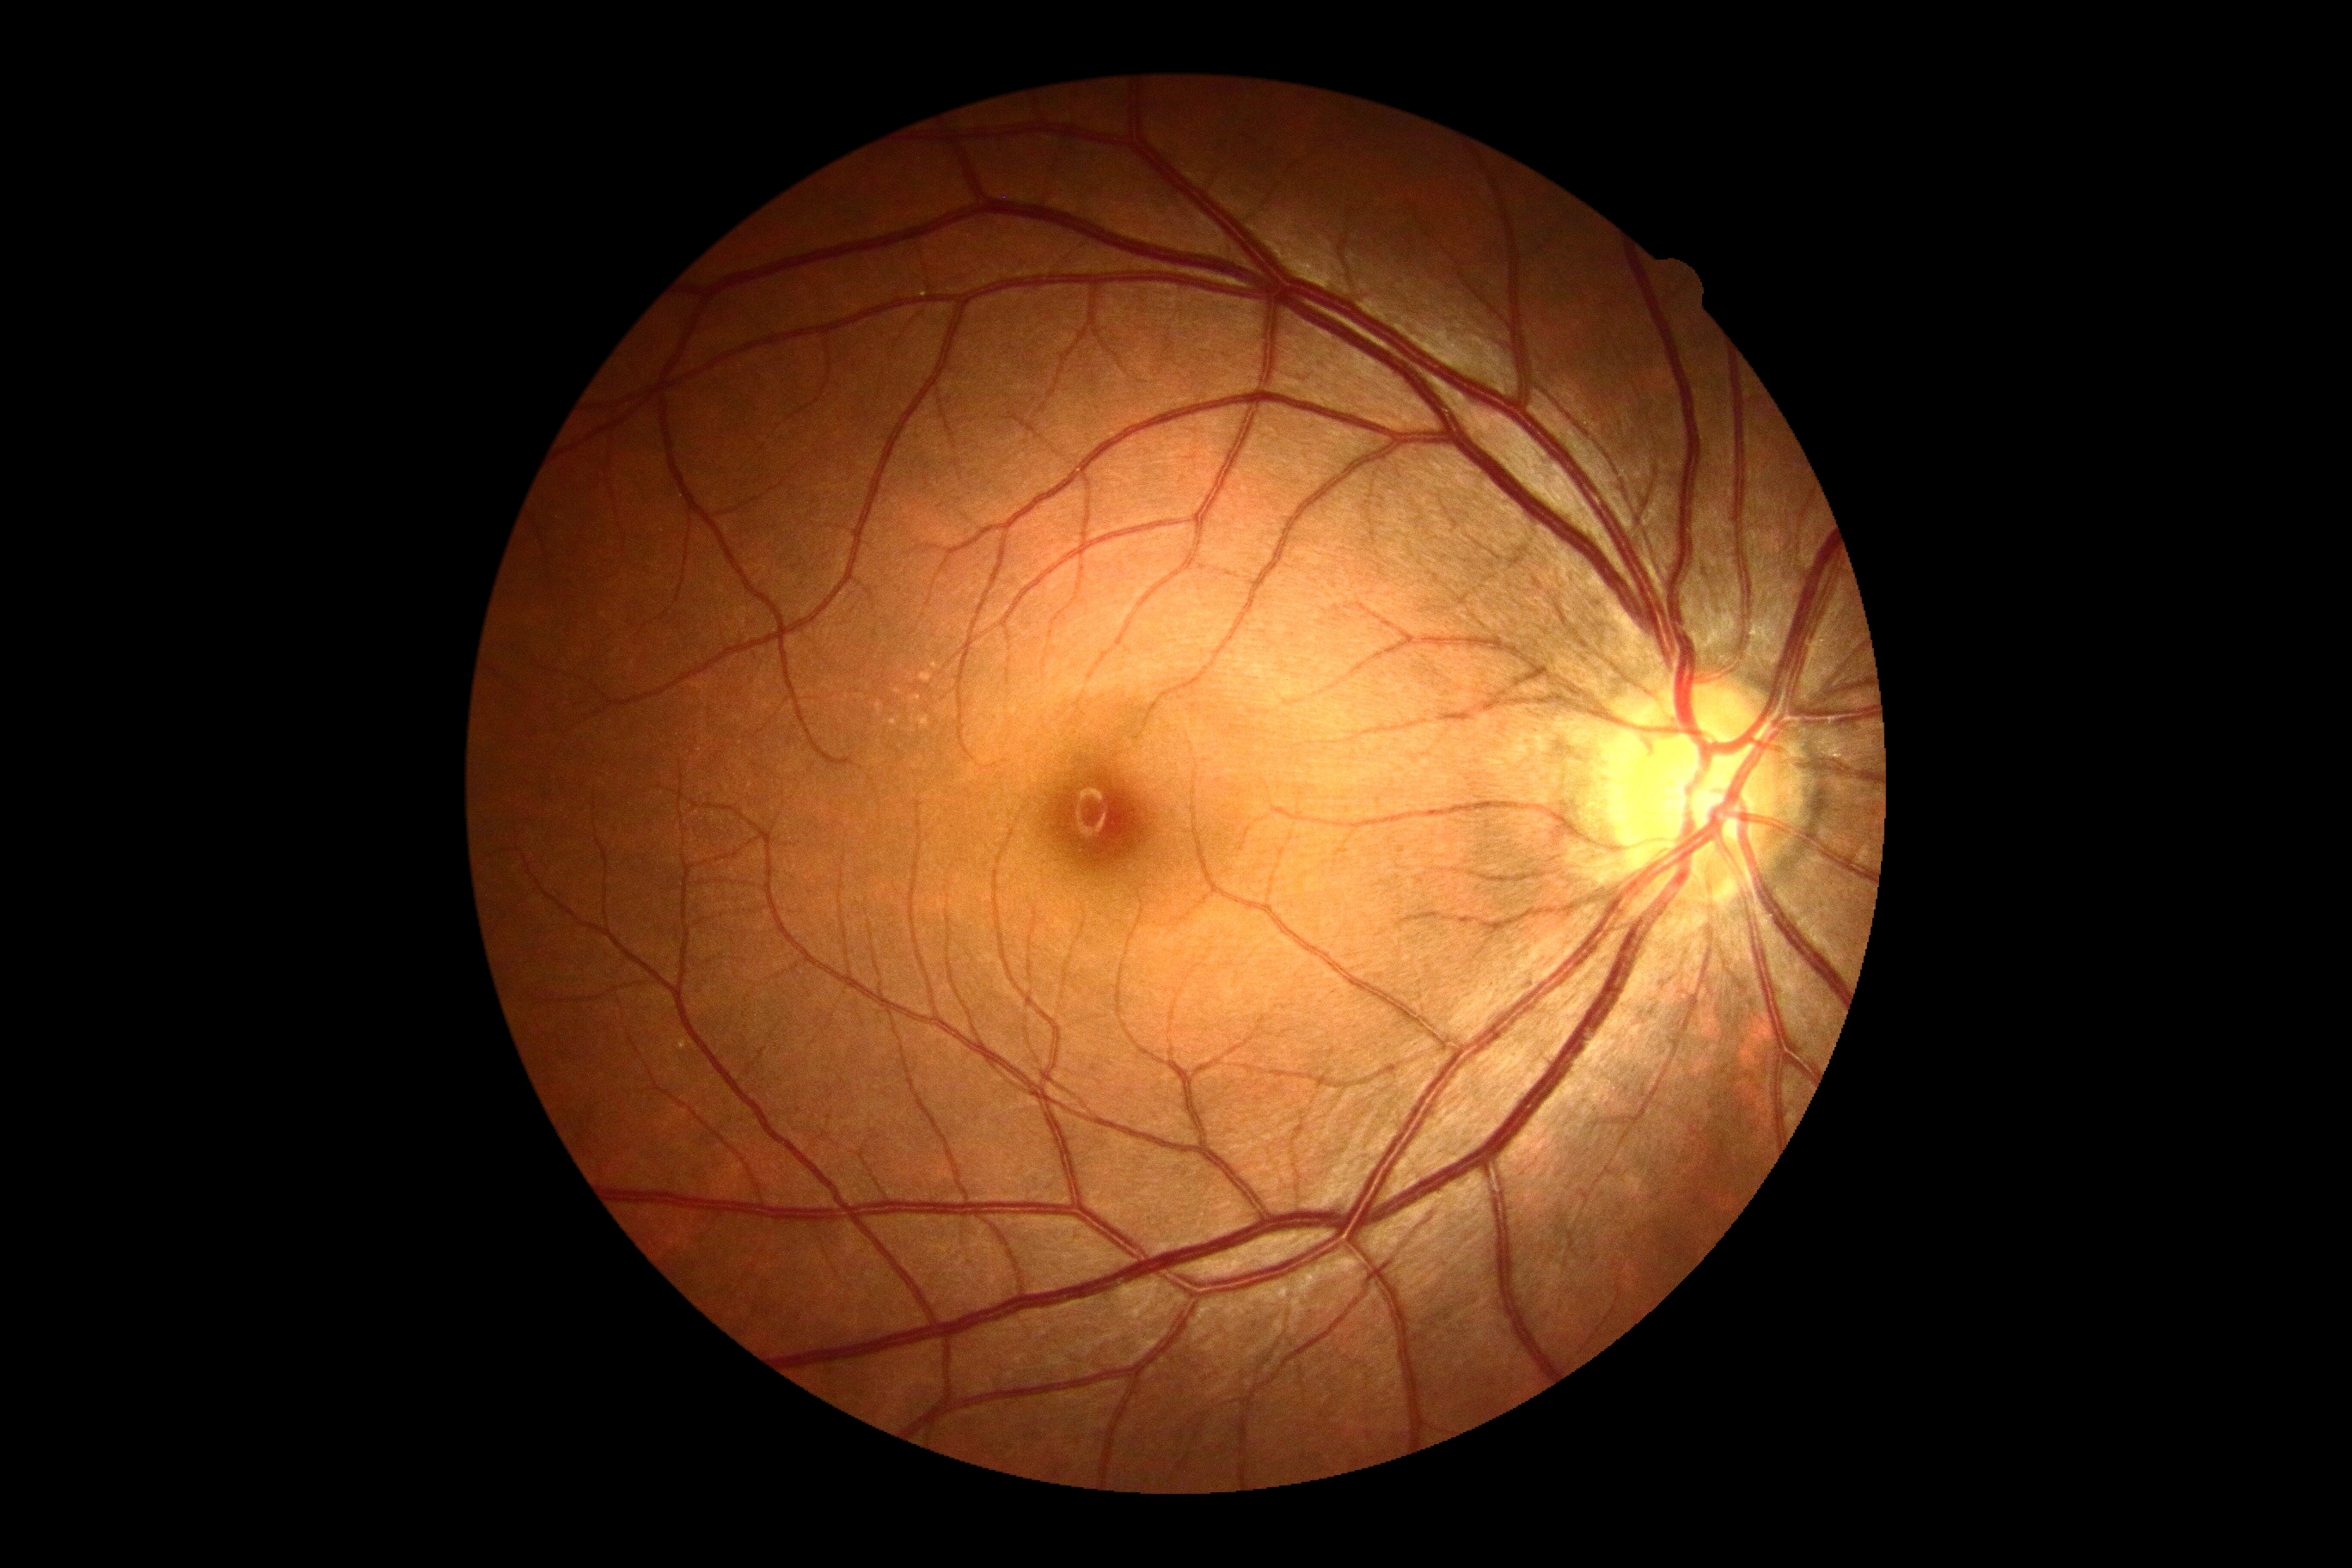 DR impression@no DR findings; DR grade@0/4.